Optic nerve head crop; captured on a Nidek AFC-330 fundus camera; non-mydriatic fundus camera
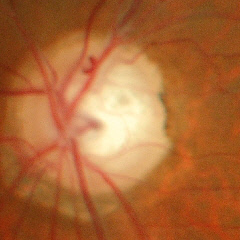
Glaucoma is present. Optic disc appearance consistent with early glaucomatous optic neuropathy. Diagnostic criteria: glaucomatous retinal nerve fiber layer defects on red-free fundus photography without visual field defects.